Graded on the modified Davis scale:
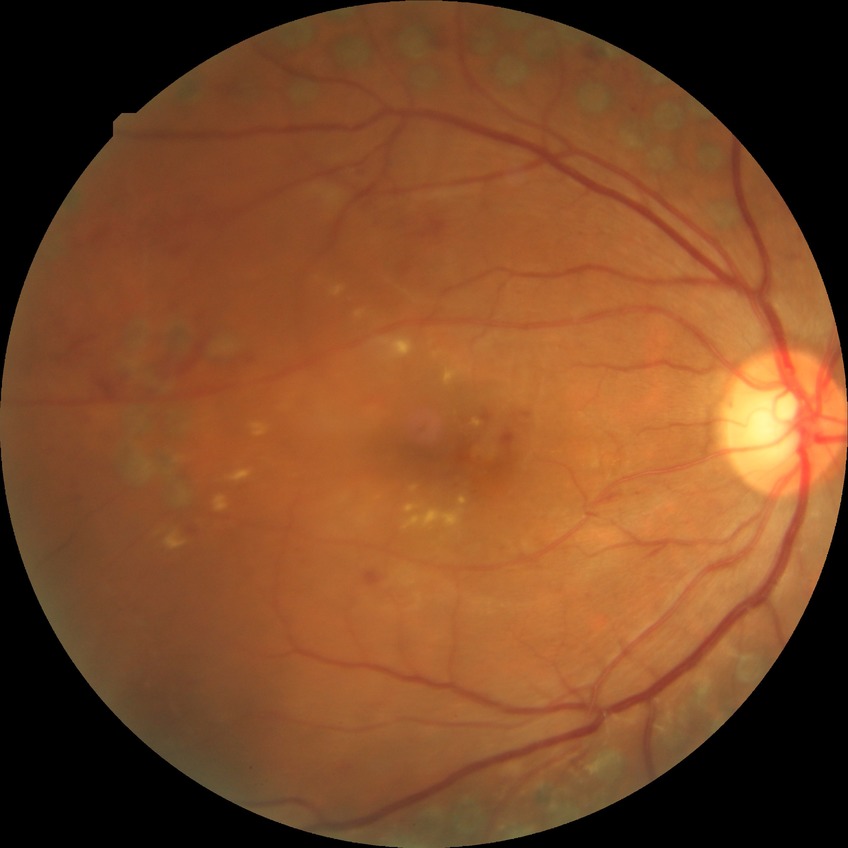
Diabetic retinopathy grade is proliferative diabetic retinopathy.